Wide-field contact fundus photograph of an infant. Image size 1440x1080. Acquired on the Natus RetCam Envision:
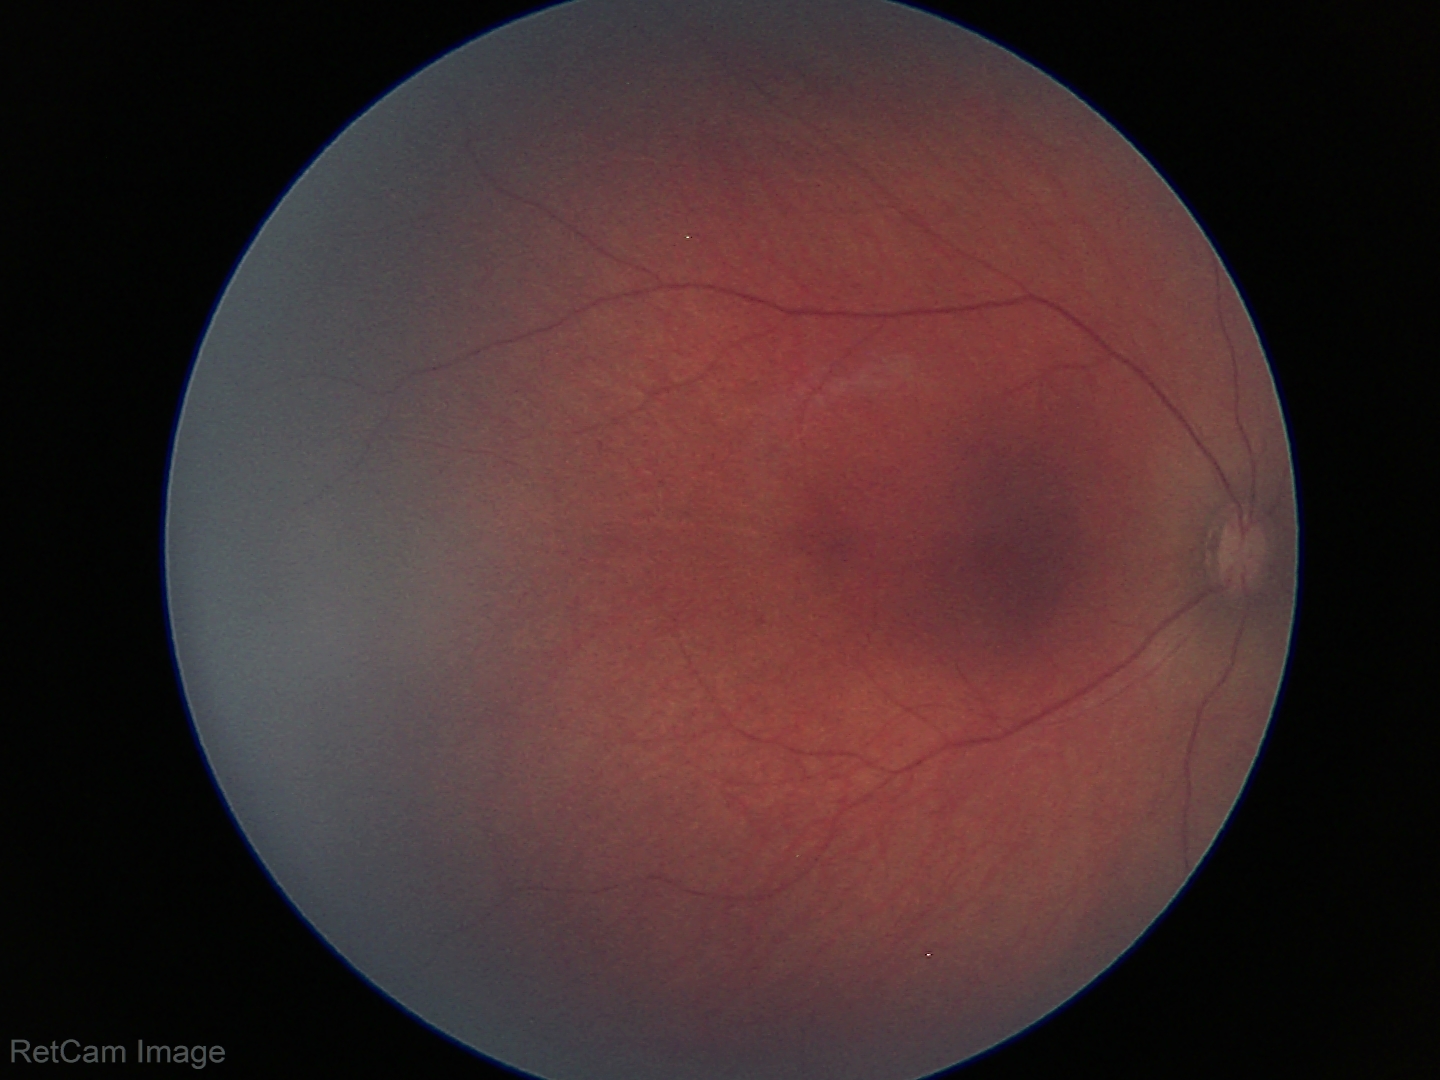

Screening: physiological appearance with no retinal pathology.